Infant wide-field retinal image · acquired on the Clarity RetCam 3 · 640 x 480 pixels.
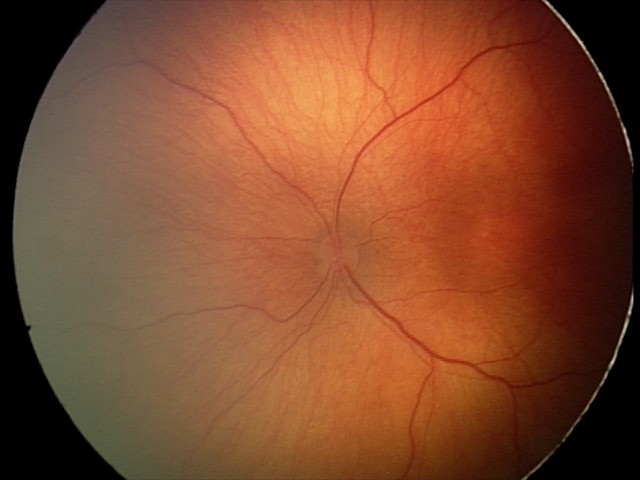

Diagnosis from this screening exam: ROP stage 2. Without plus disease.